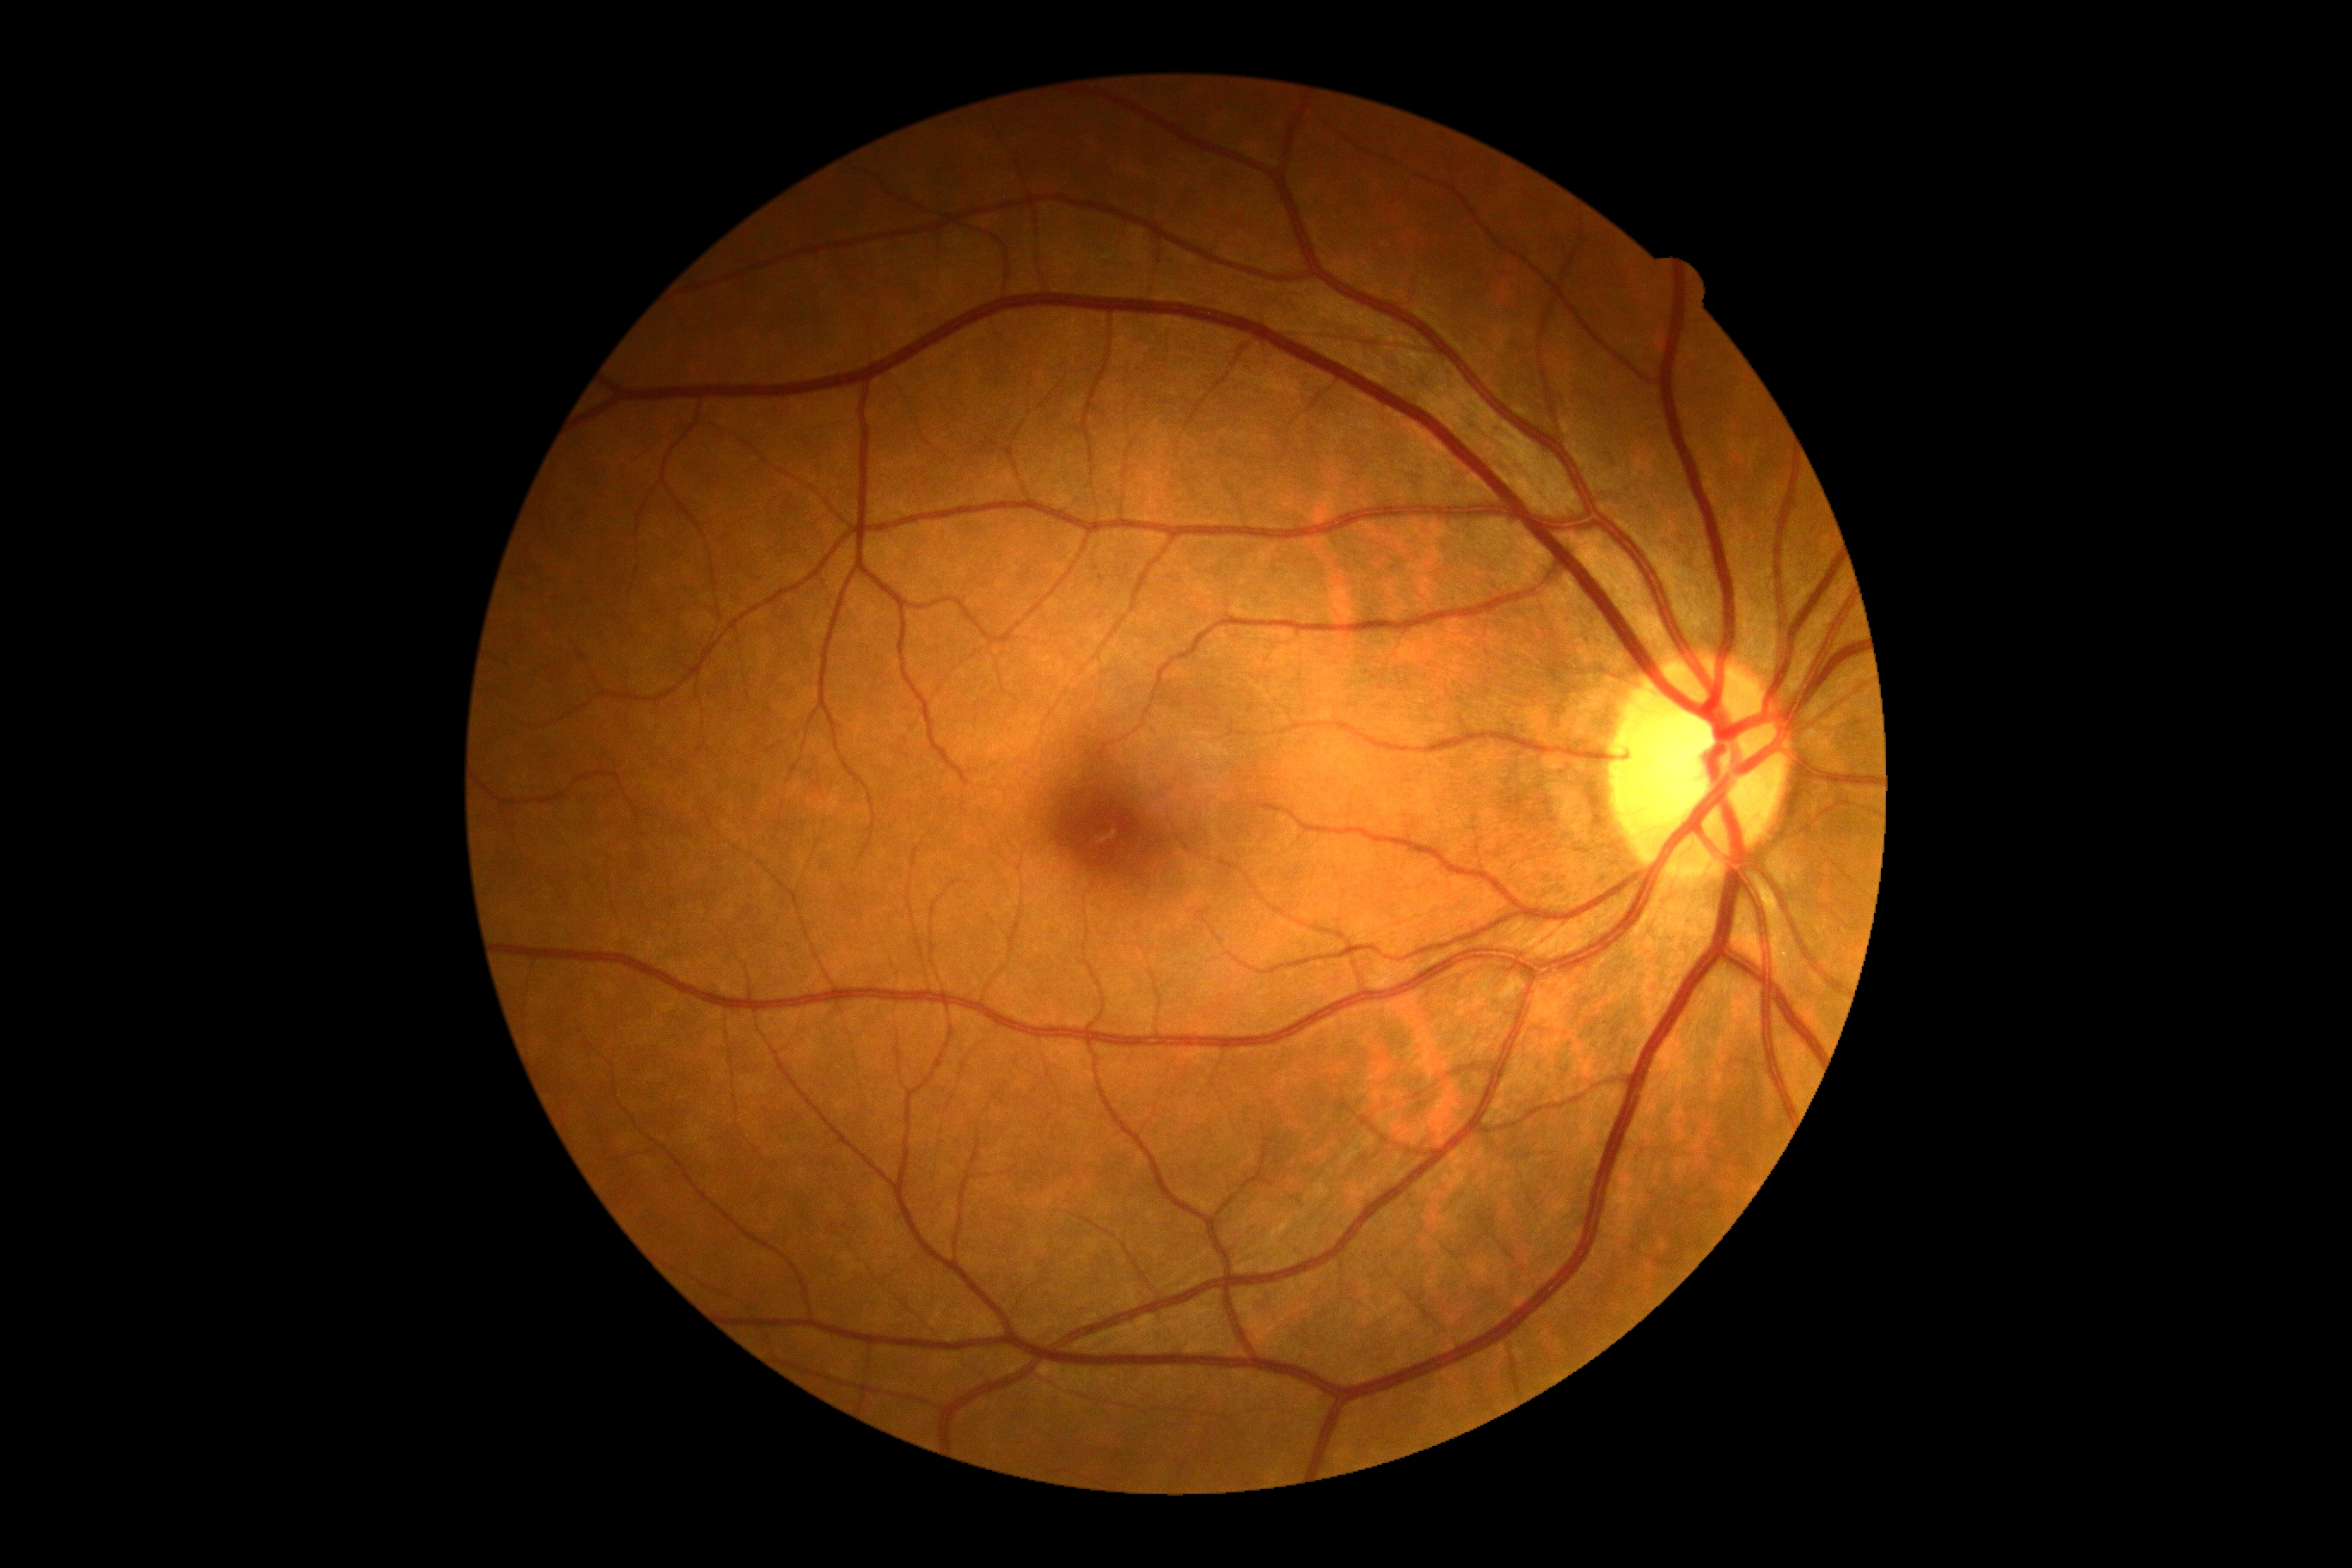
diabetic retinopathy (DR): no apparent diabetic retinopathy (grade 0) — no visible signs of diabetic retinopathy.